Wide-field fundus photograph of an infant:
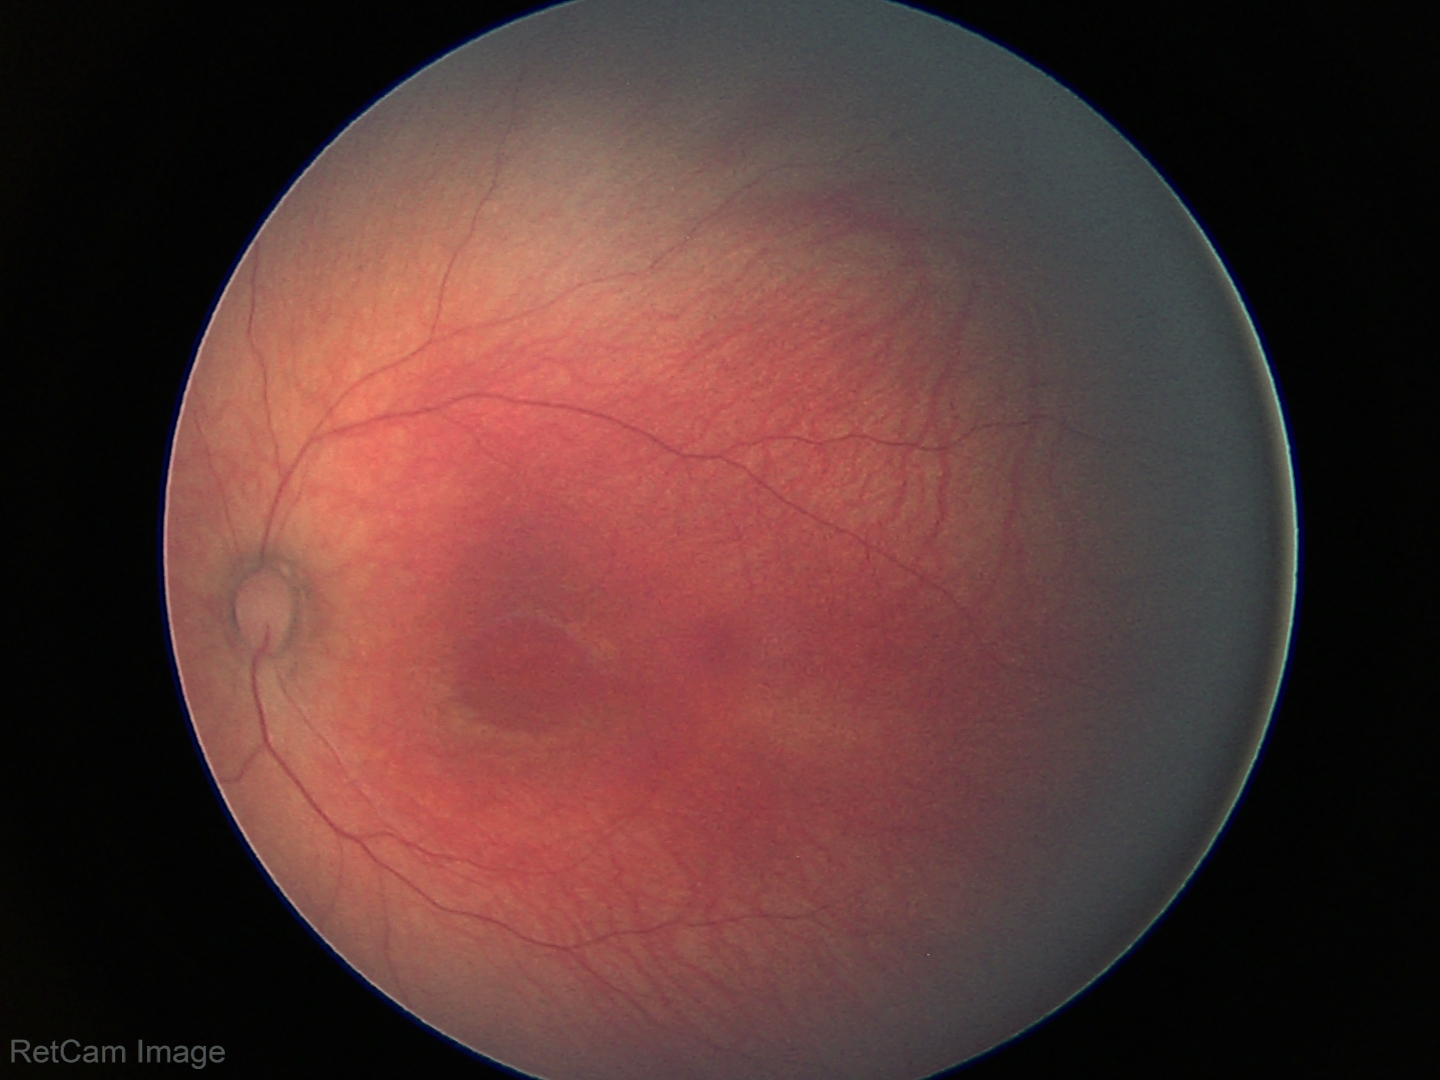
Screening: physiological appearance with no retinal pathology.